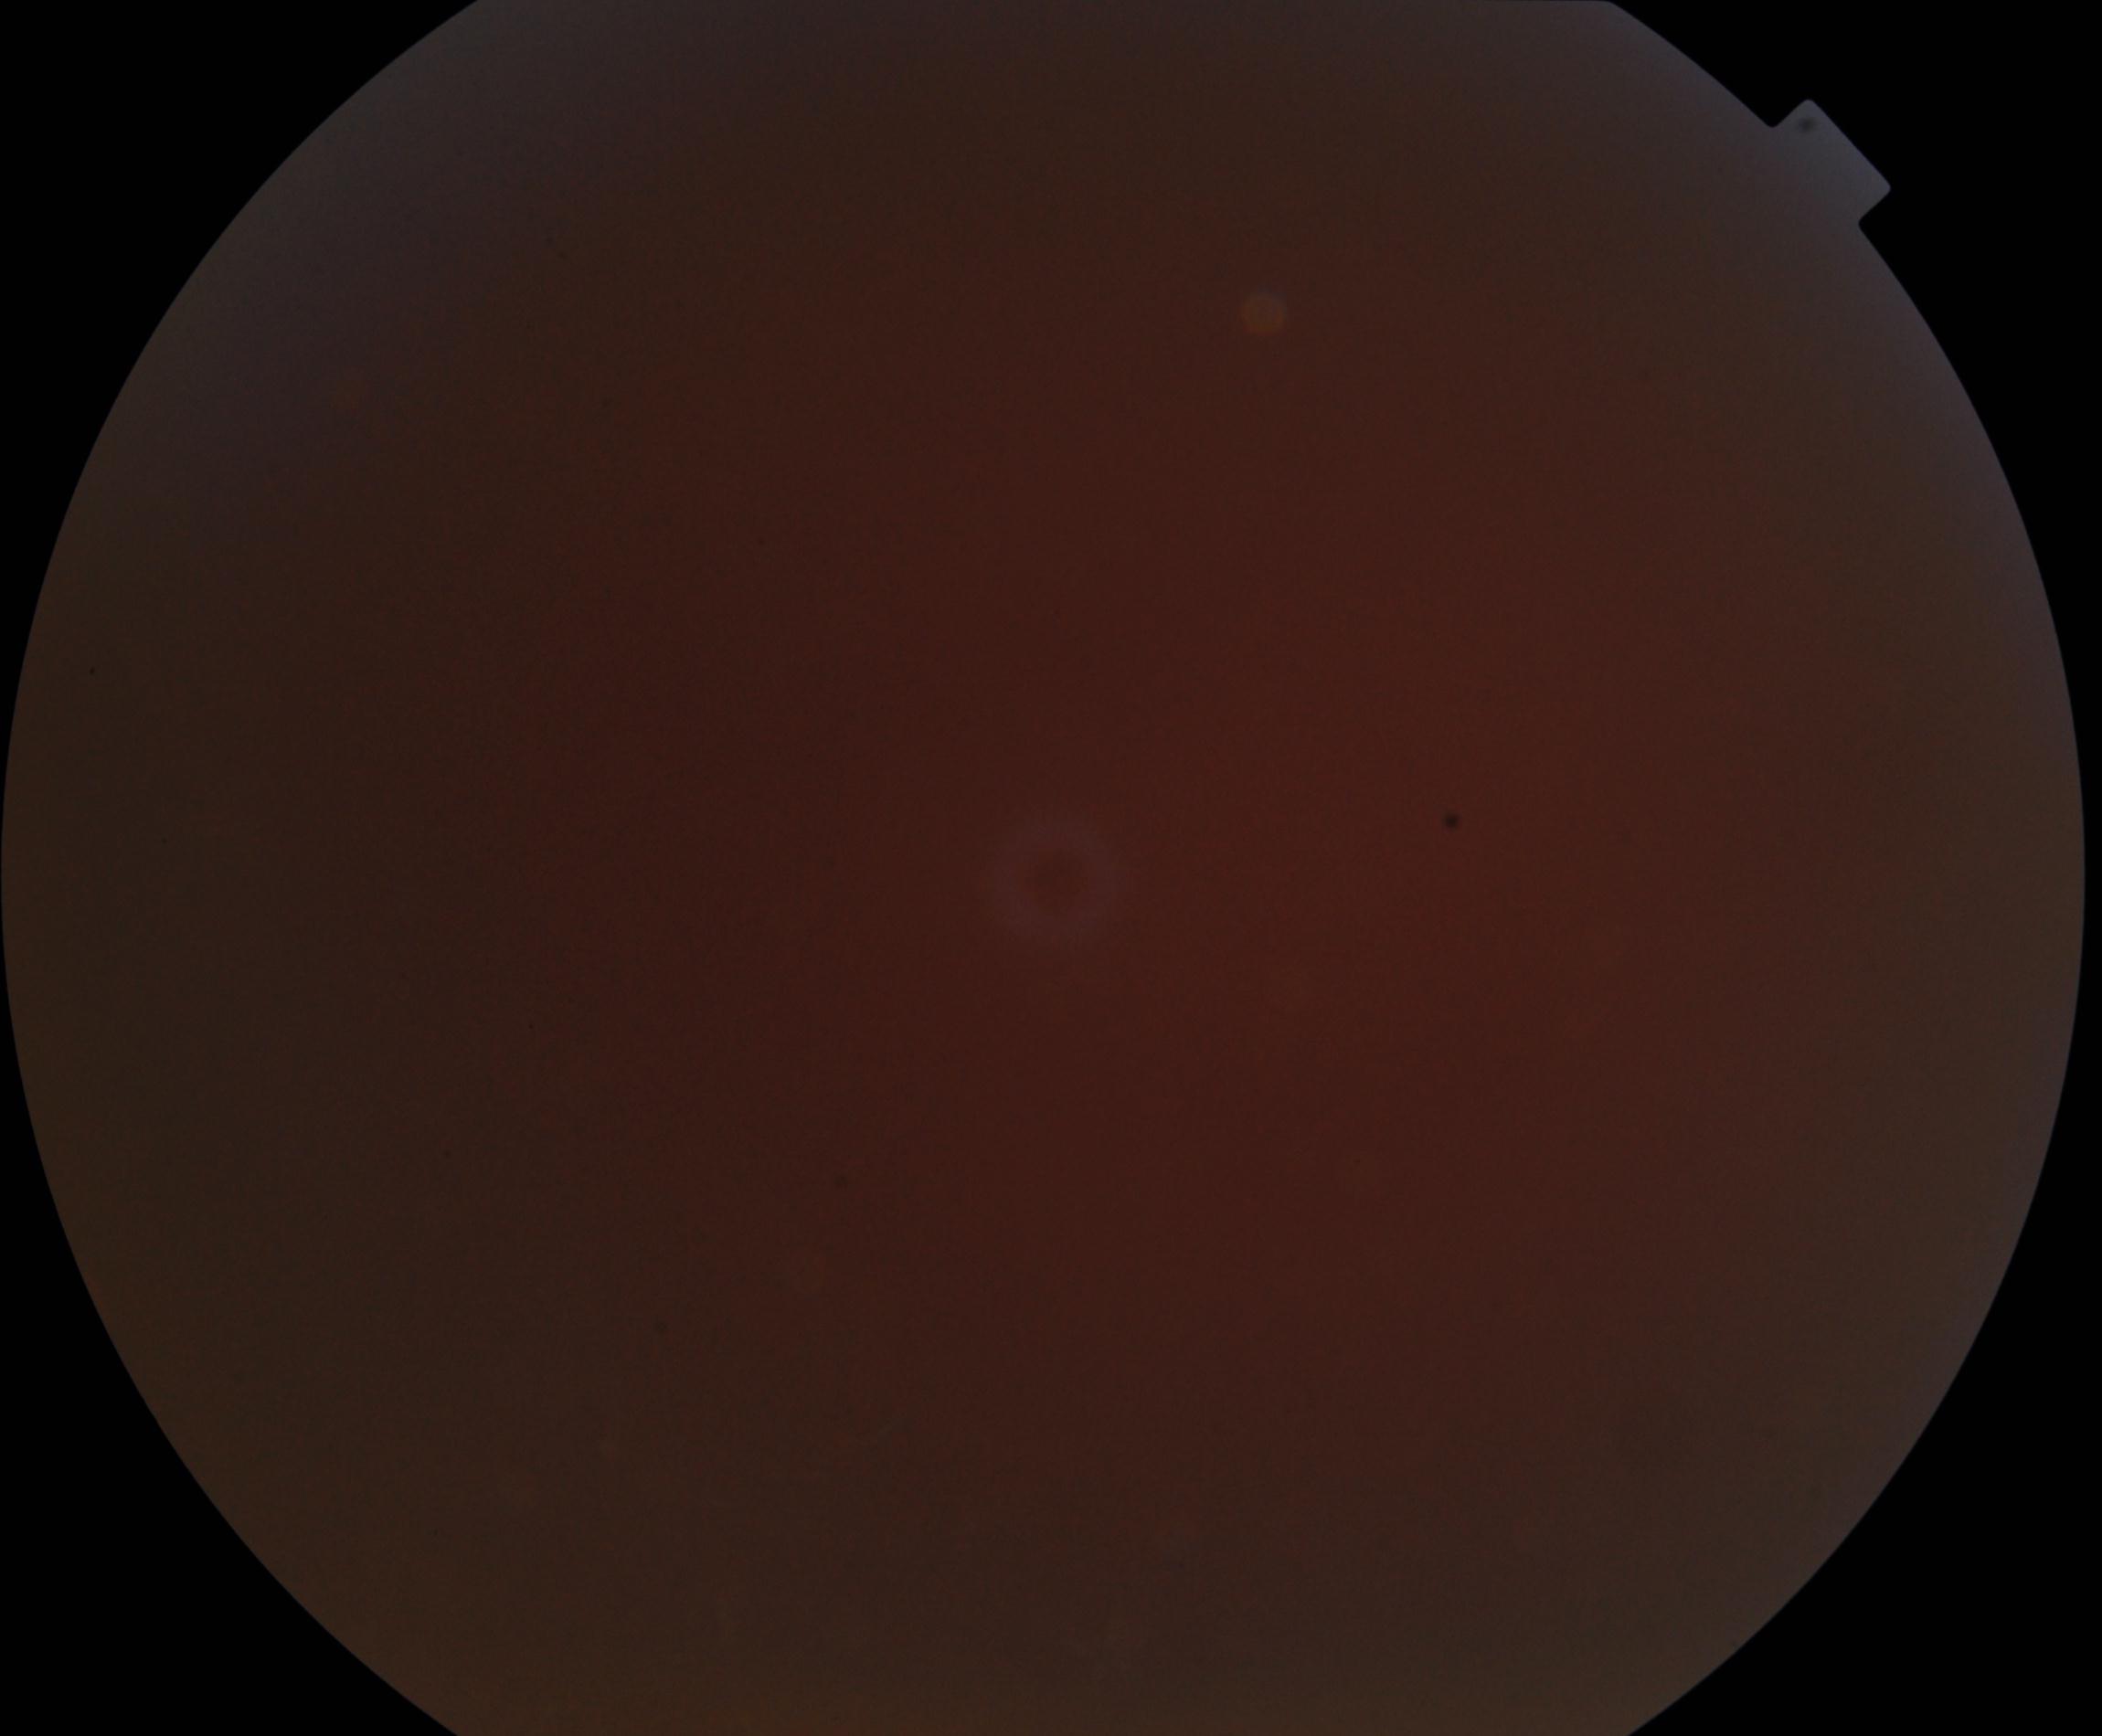

Image is blurred; retinal landmarks are largely obscured. No proliferative diabetic retinopathy identified.